Clarity RetCam 3, 130° FOV. Pediatric wide-field fundus photograph.
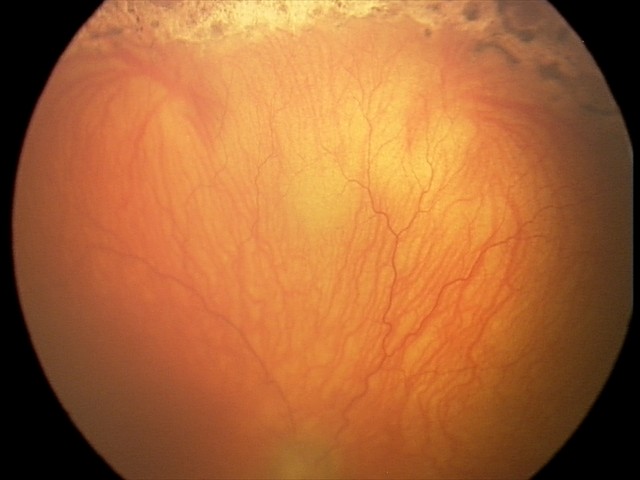
Diagnosis from this screening exam: A-ROP (aggressive ROP). With plus disease.